Modified Davis classification · 45° FOV · CFP:
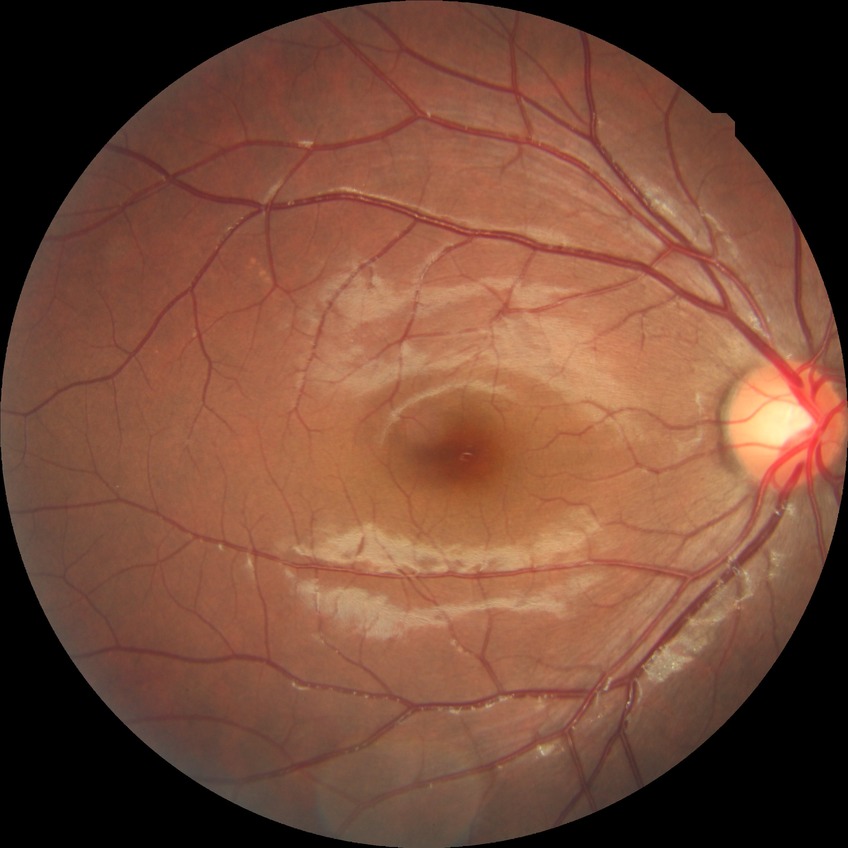

Modified Davis grading: no diabetic retinopathy.